CFP:
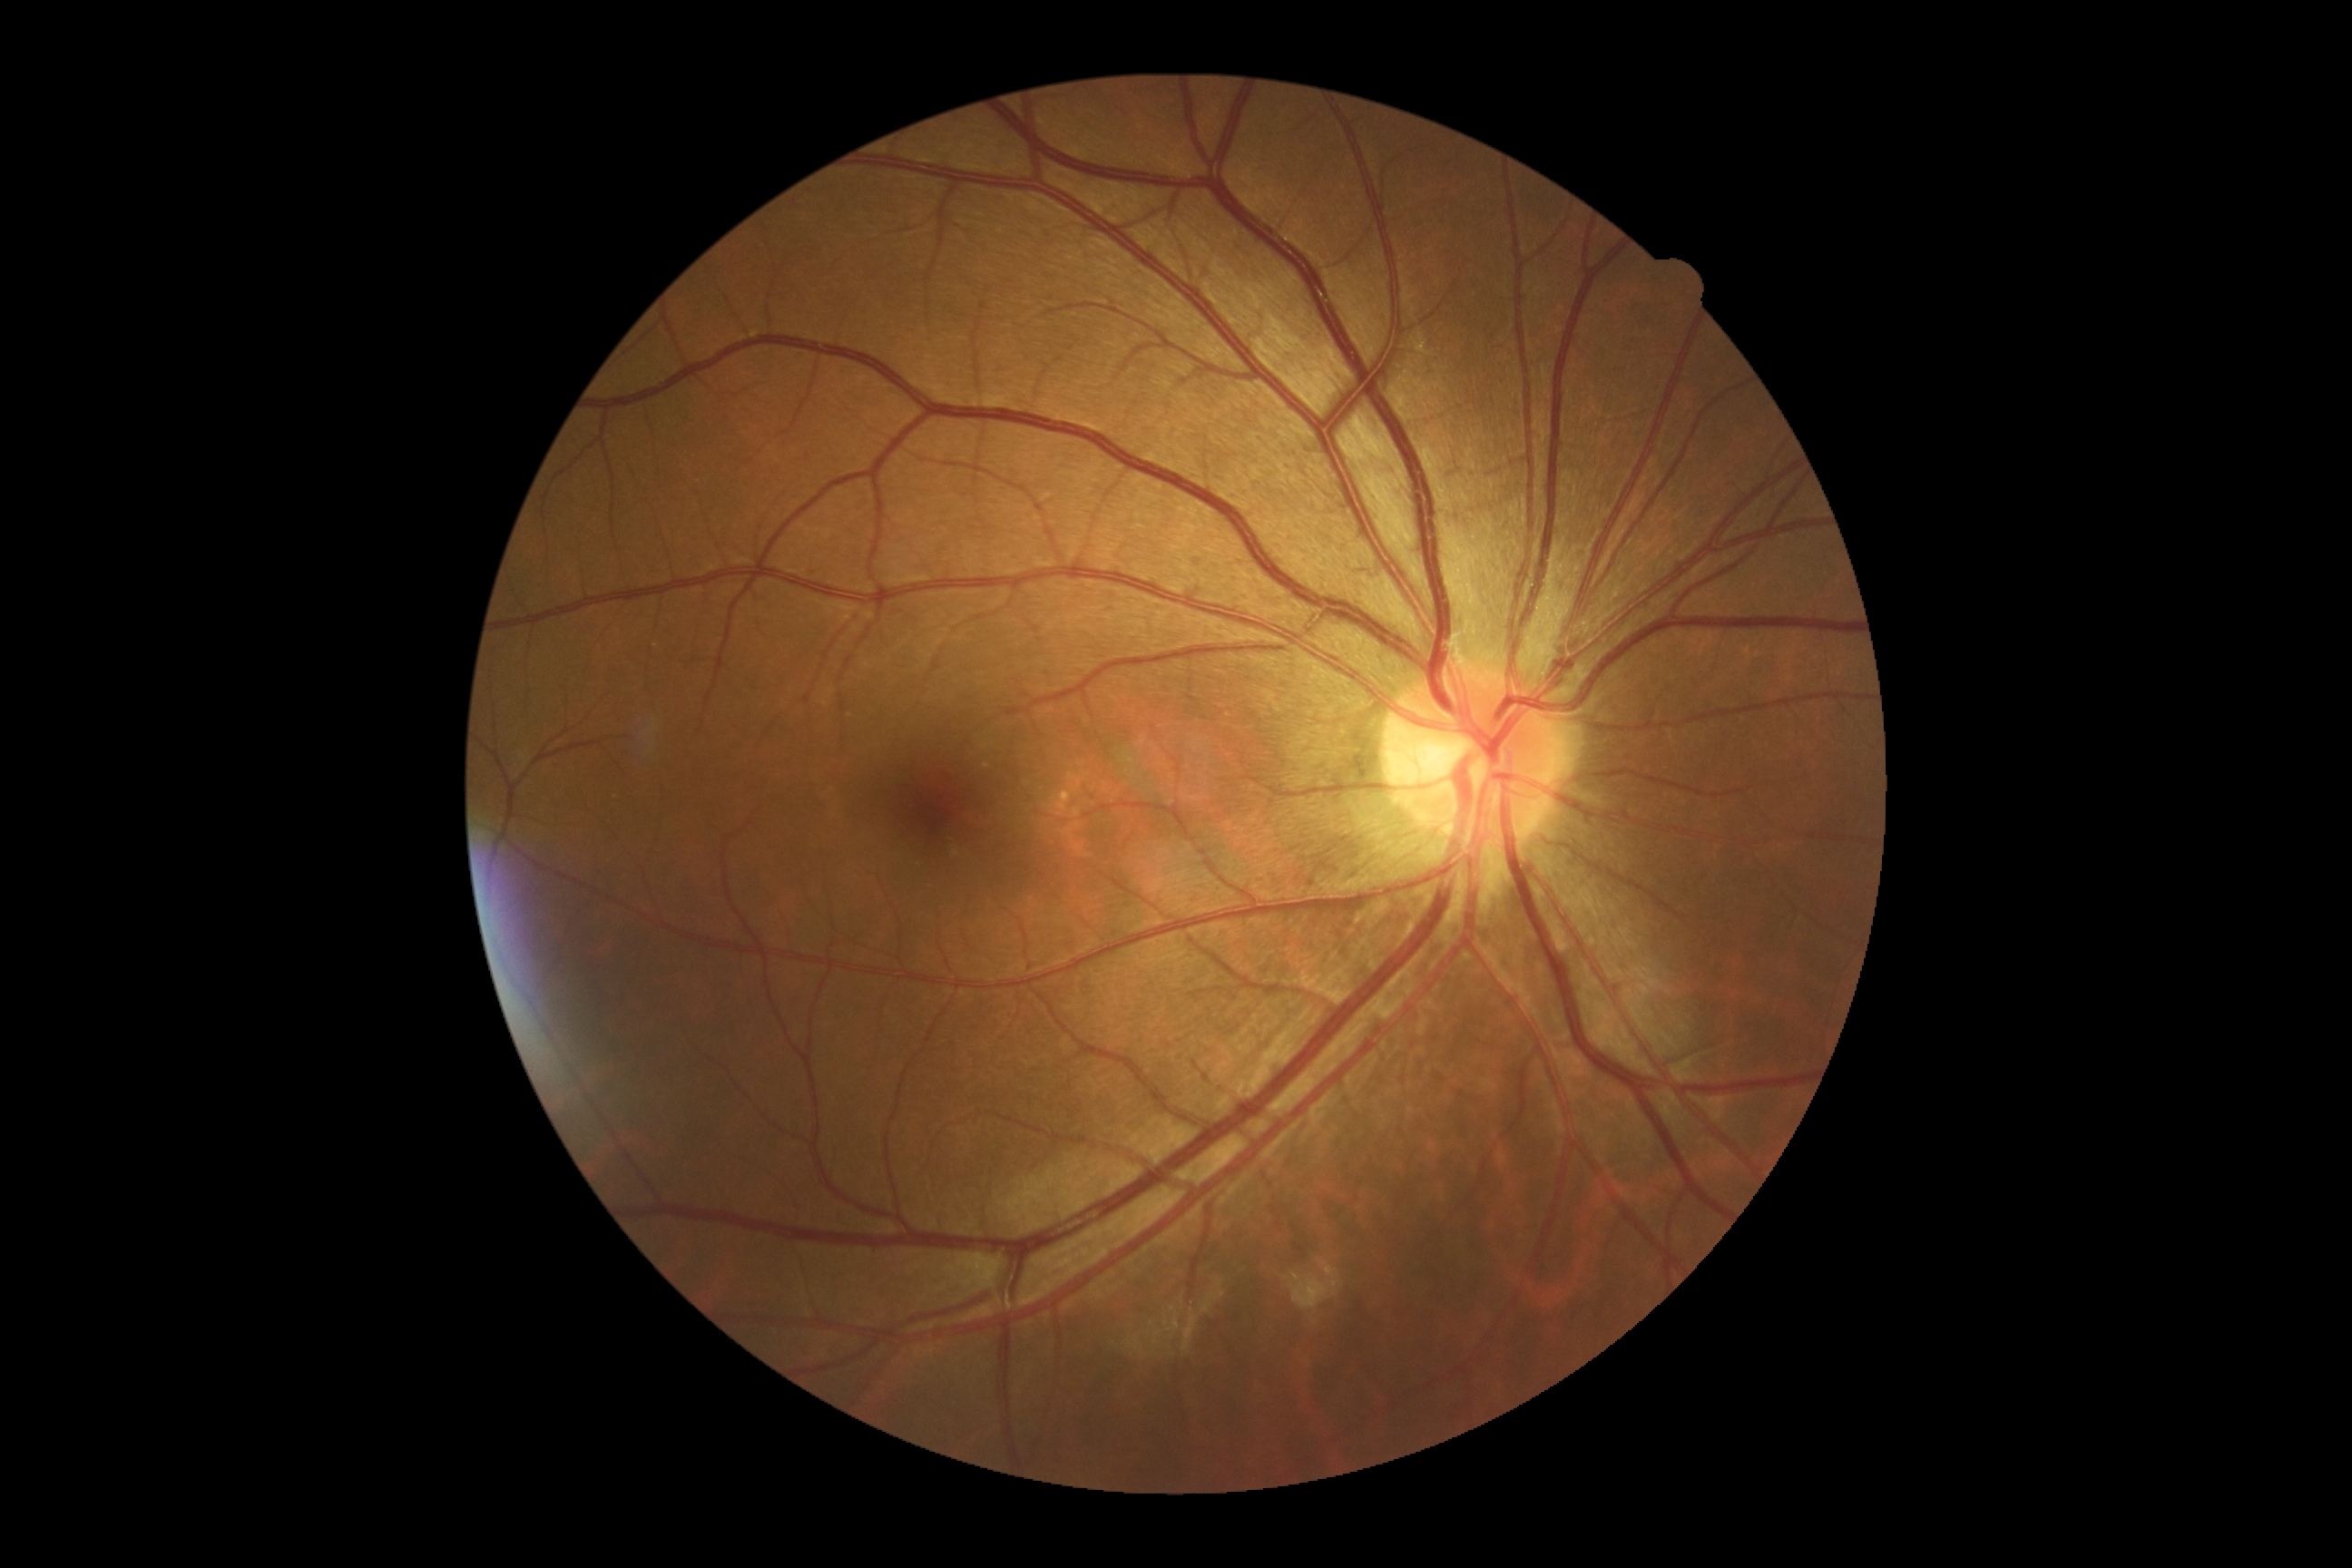

Diabetic retinopathy: grade 0 (no apparent retinopathy).